45° field of view, image size 2352x1568, fundus photo.
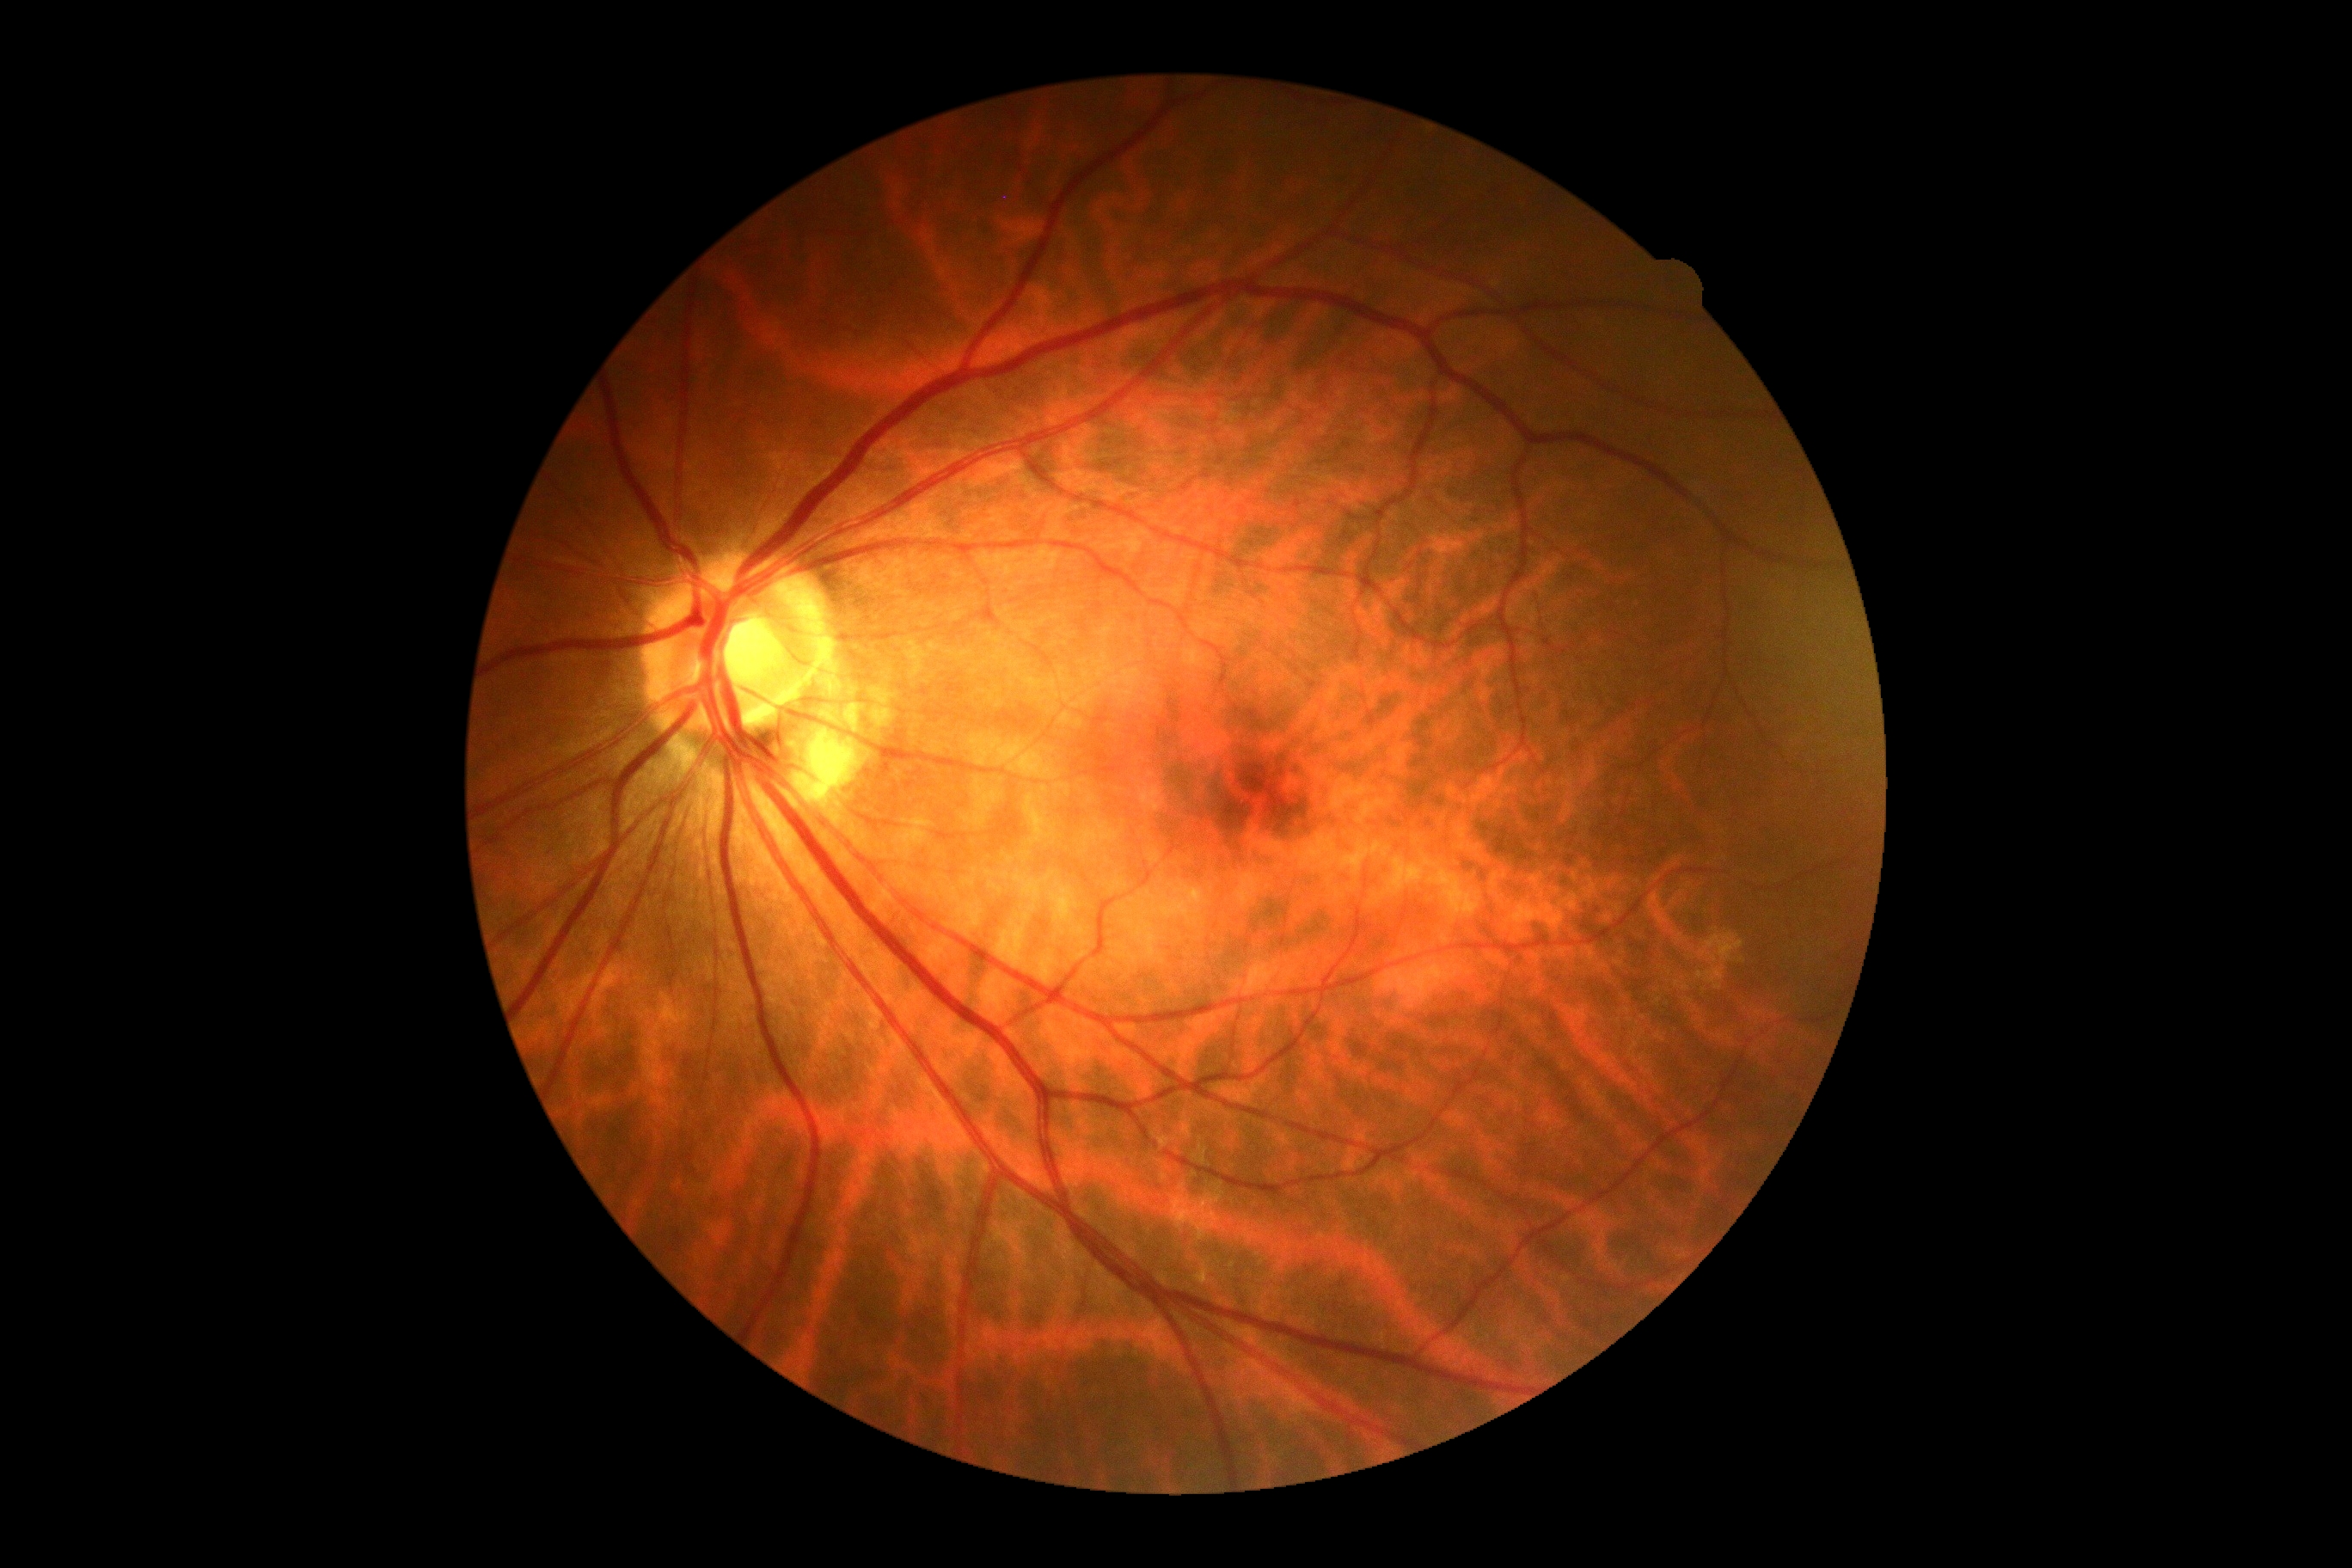 retinopathy grade=0/4.